Image size 1240x1240. Pediatric retinal photograph (wide-field). Phoenix ICON, 100° FOV
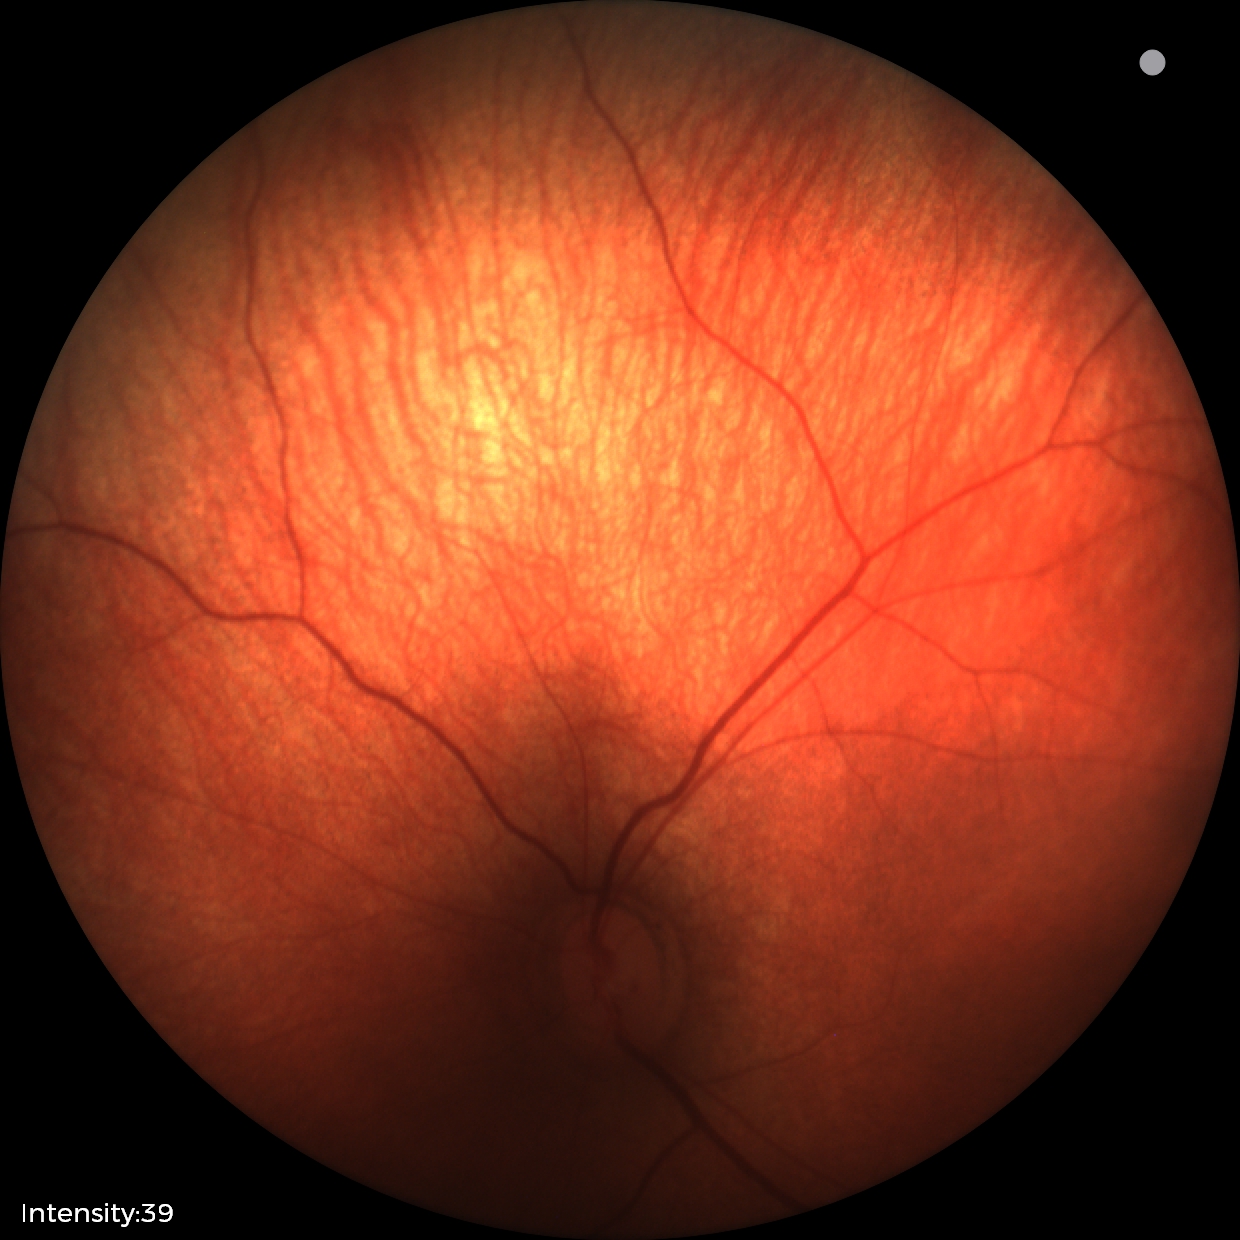 Q: What is the diagnosis from this examination?
A: no abnormal retinal findings